2352 by 1568 pixels; 45-degree field of view; CFP.
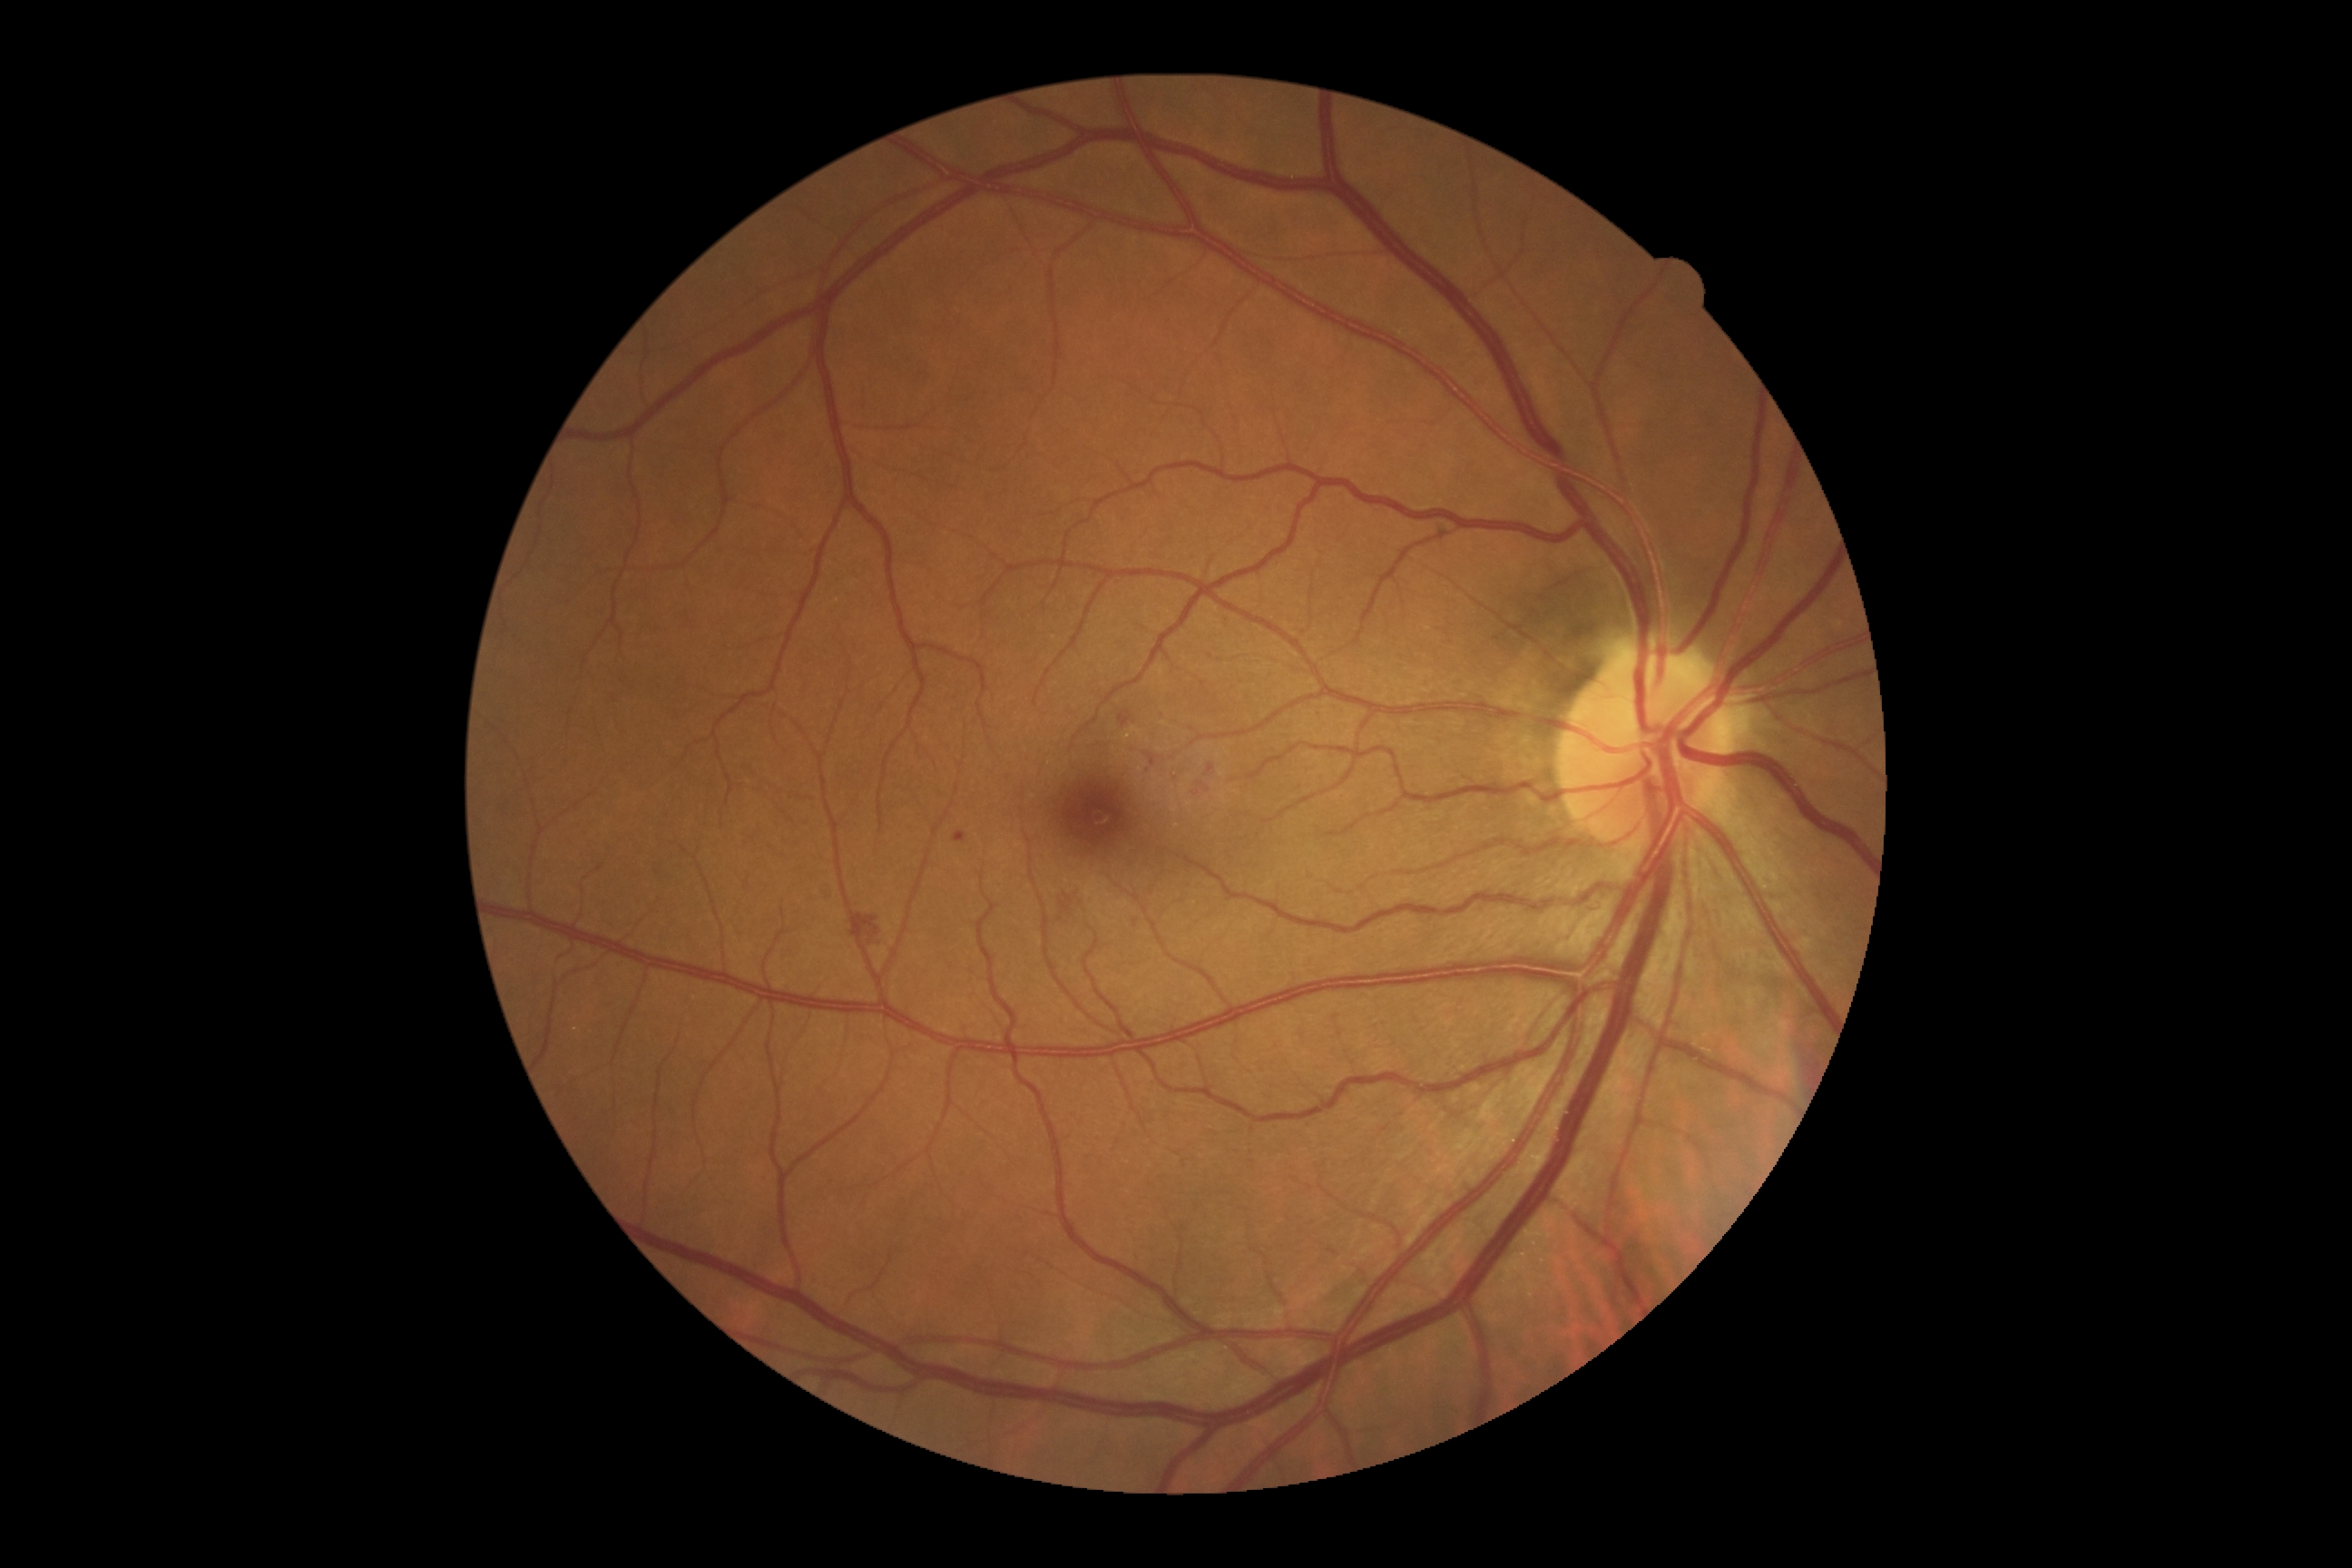 {
  "dr_grade": "moderate NPDR (grade 2)"
}